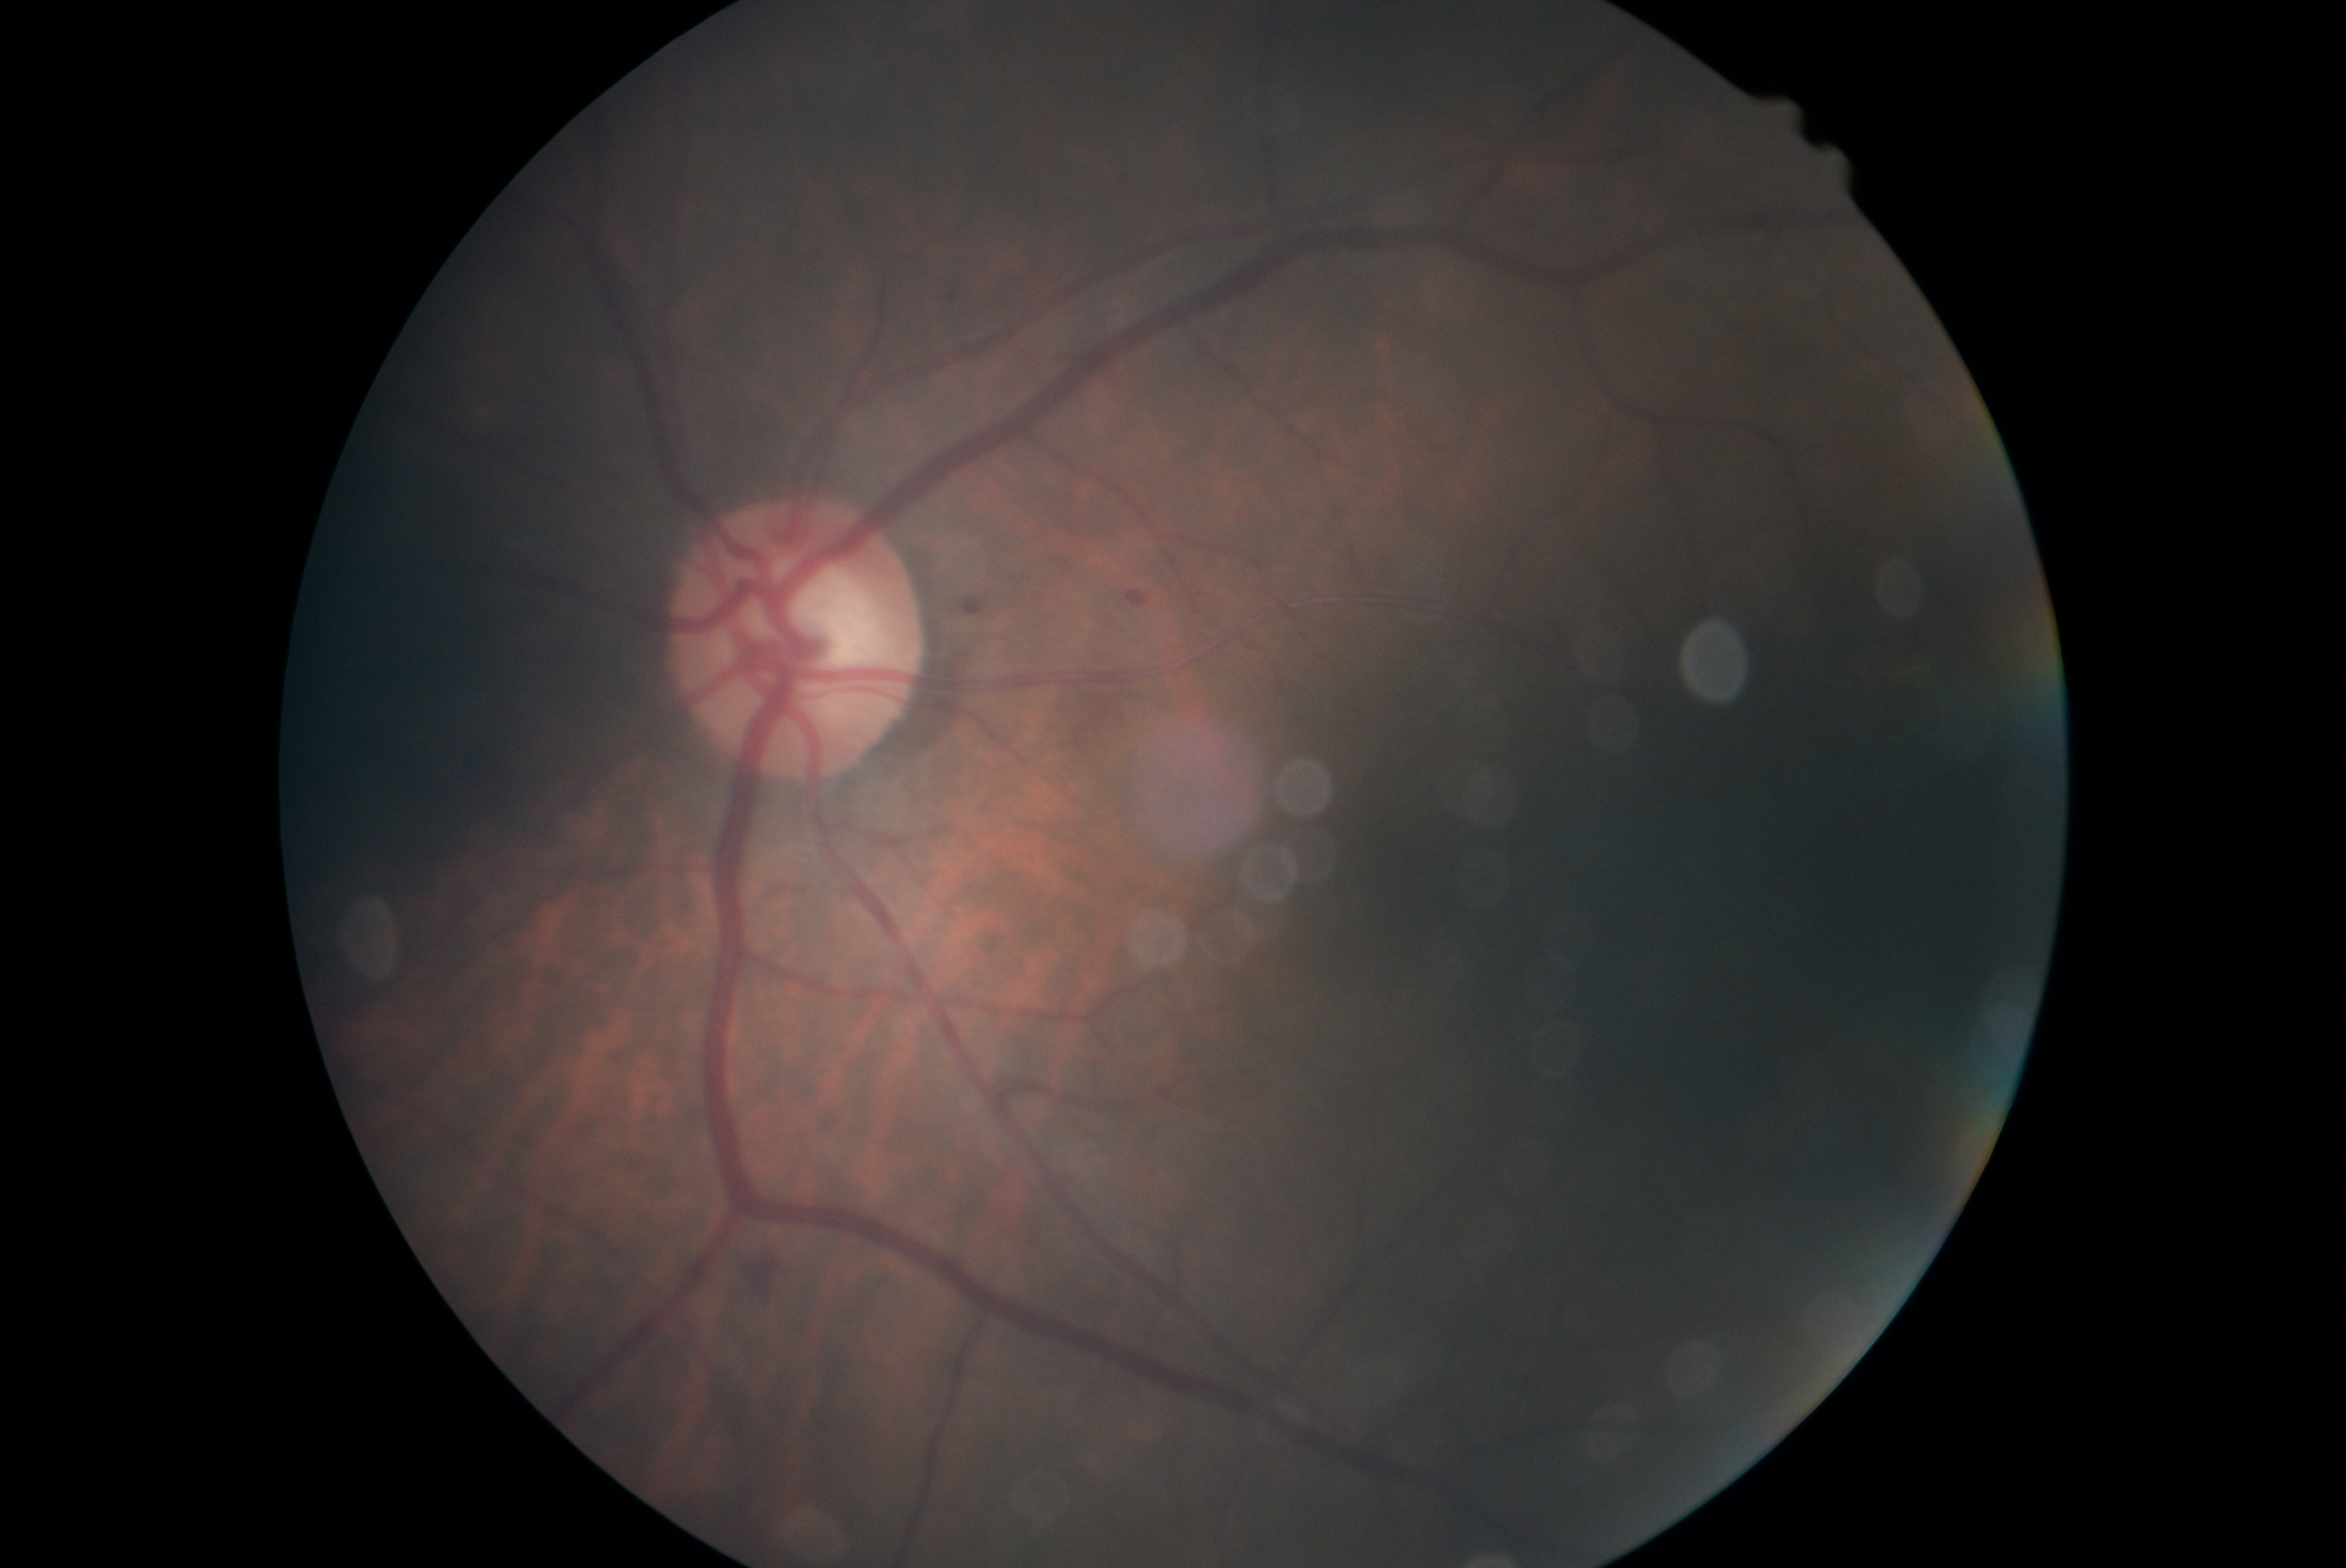

The retinopathy is classified as non-proliferative diabetic retinopathy.
Diabetic retinopathy severity is grade 2 (moderate NPDR).